Acquired with a NIDEK AFC-230; FOV: 45 degrees:
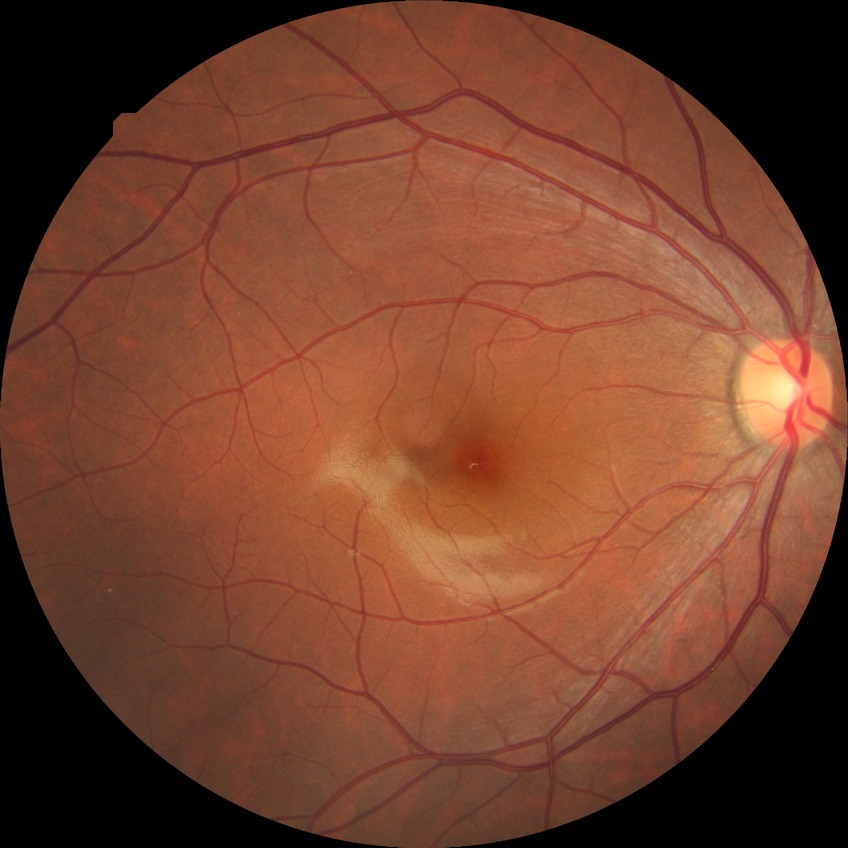

Diabetic retinopathy (DR): no diabetic retinopathy (NDR).